2048 x 1536 pixels.
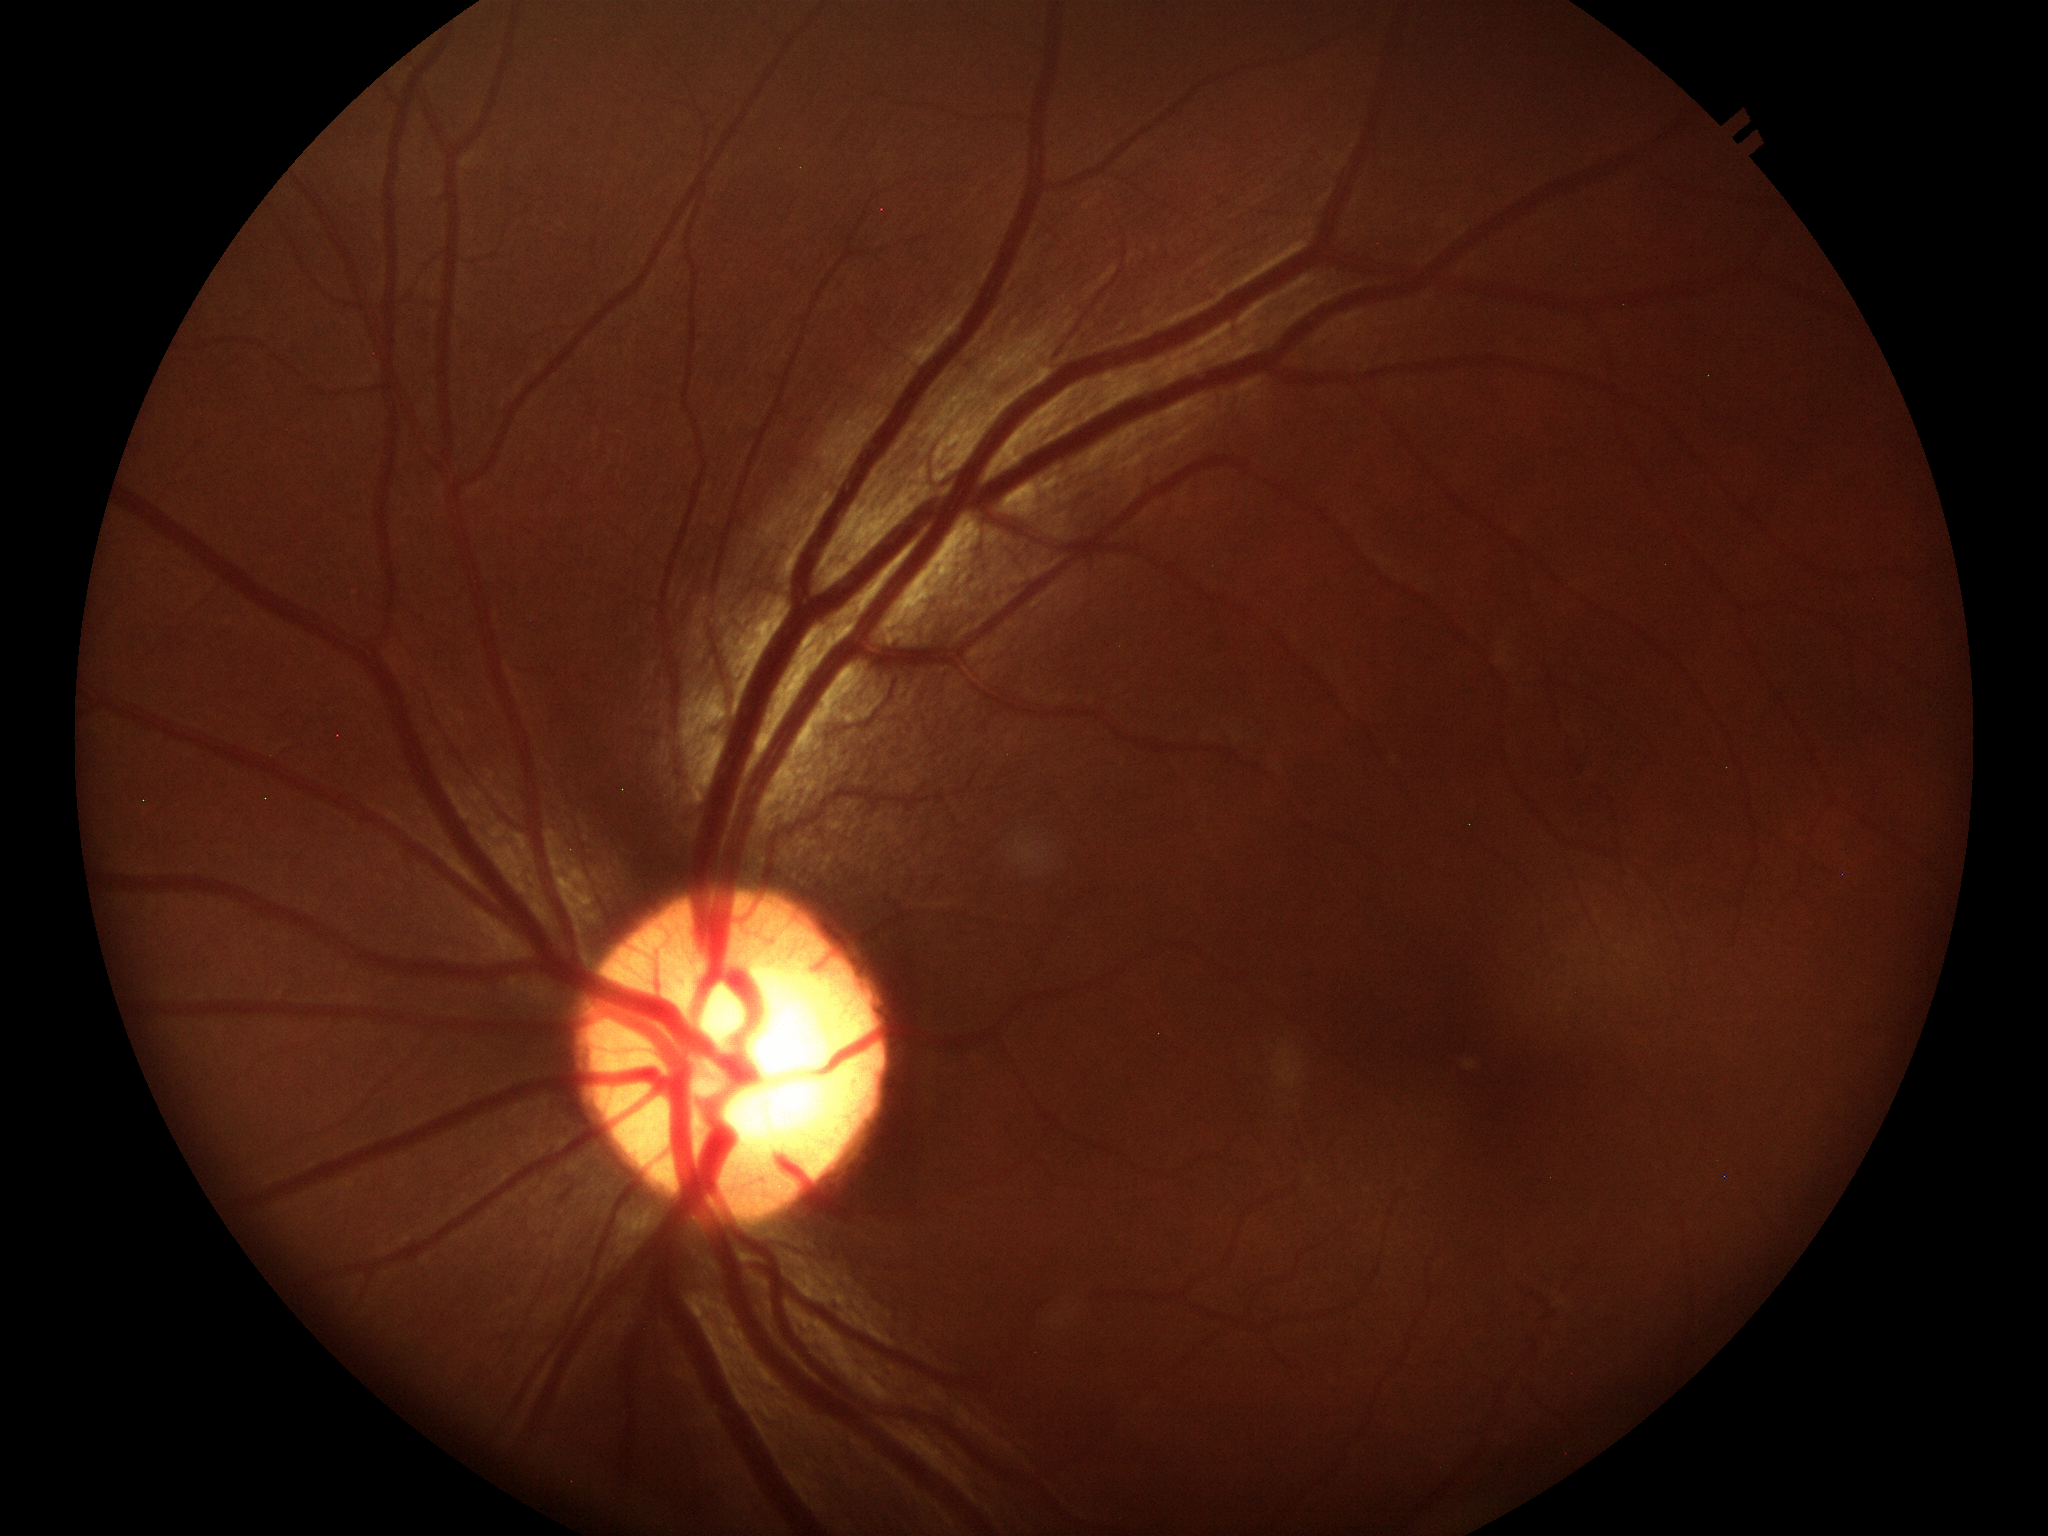

Findings suspicious for glaucoma.
Vertical cup-disc ratio (VCDR) is 0.60.